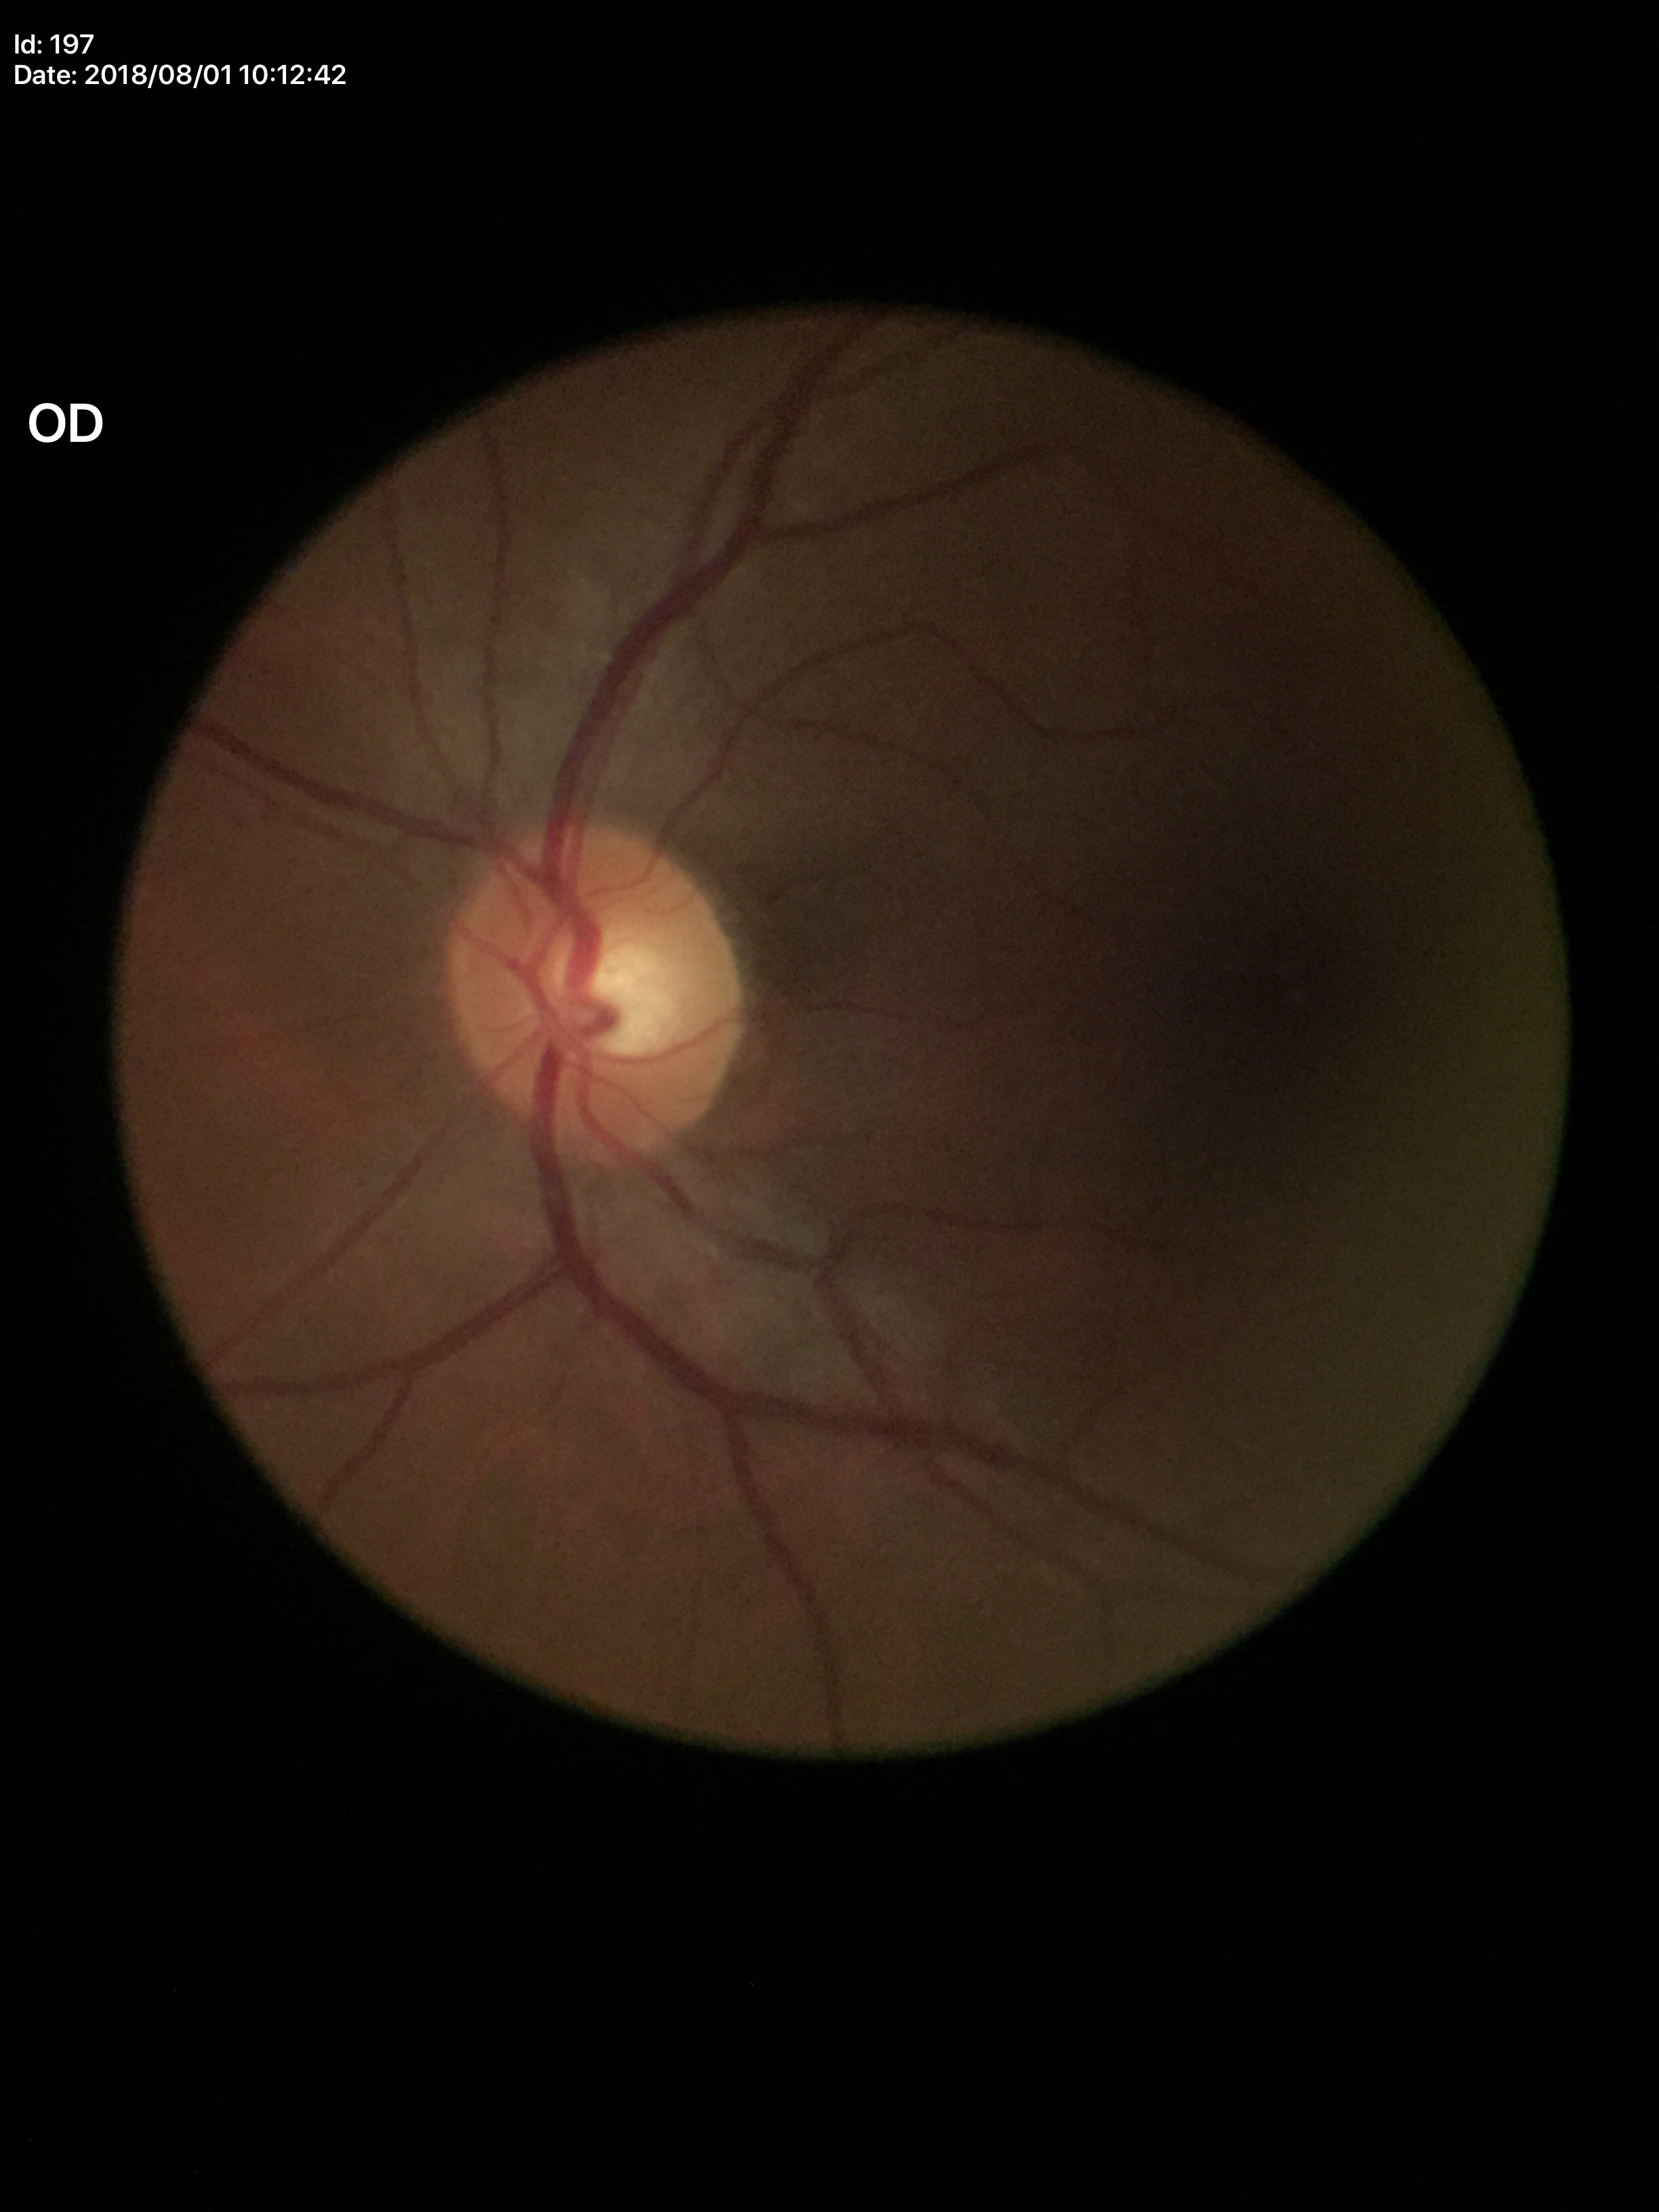 No glaucomatous optic neuropathy. VCDR: 0.49. HCDR of 0.54.